CFP.
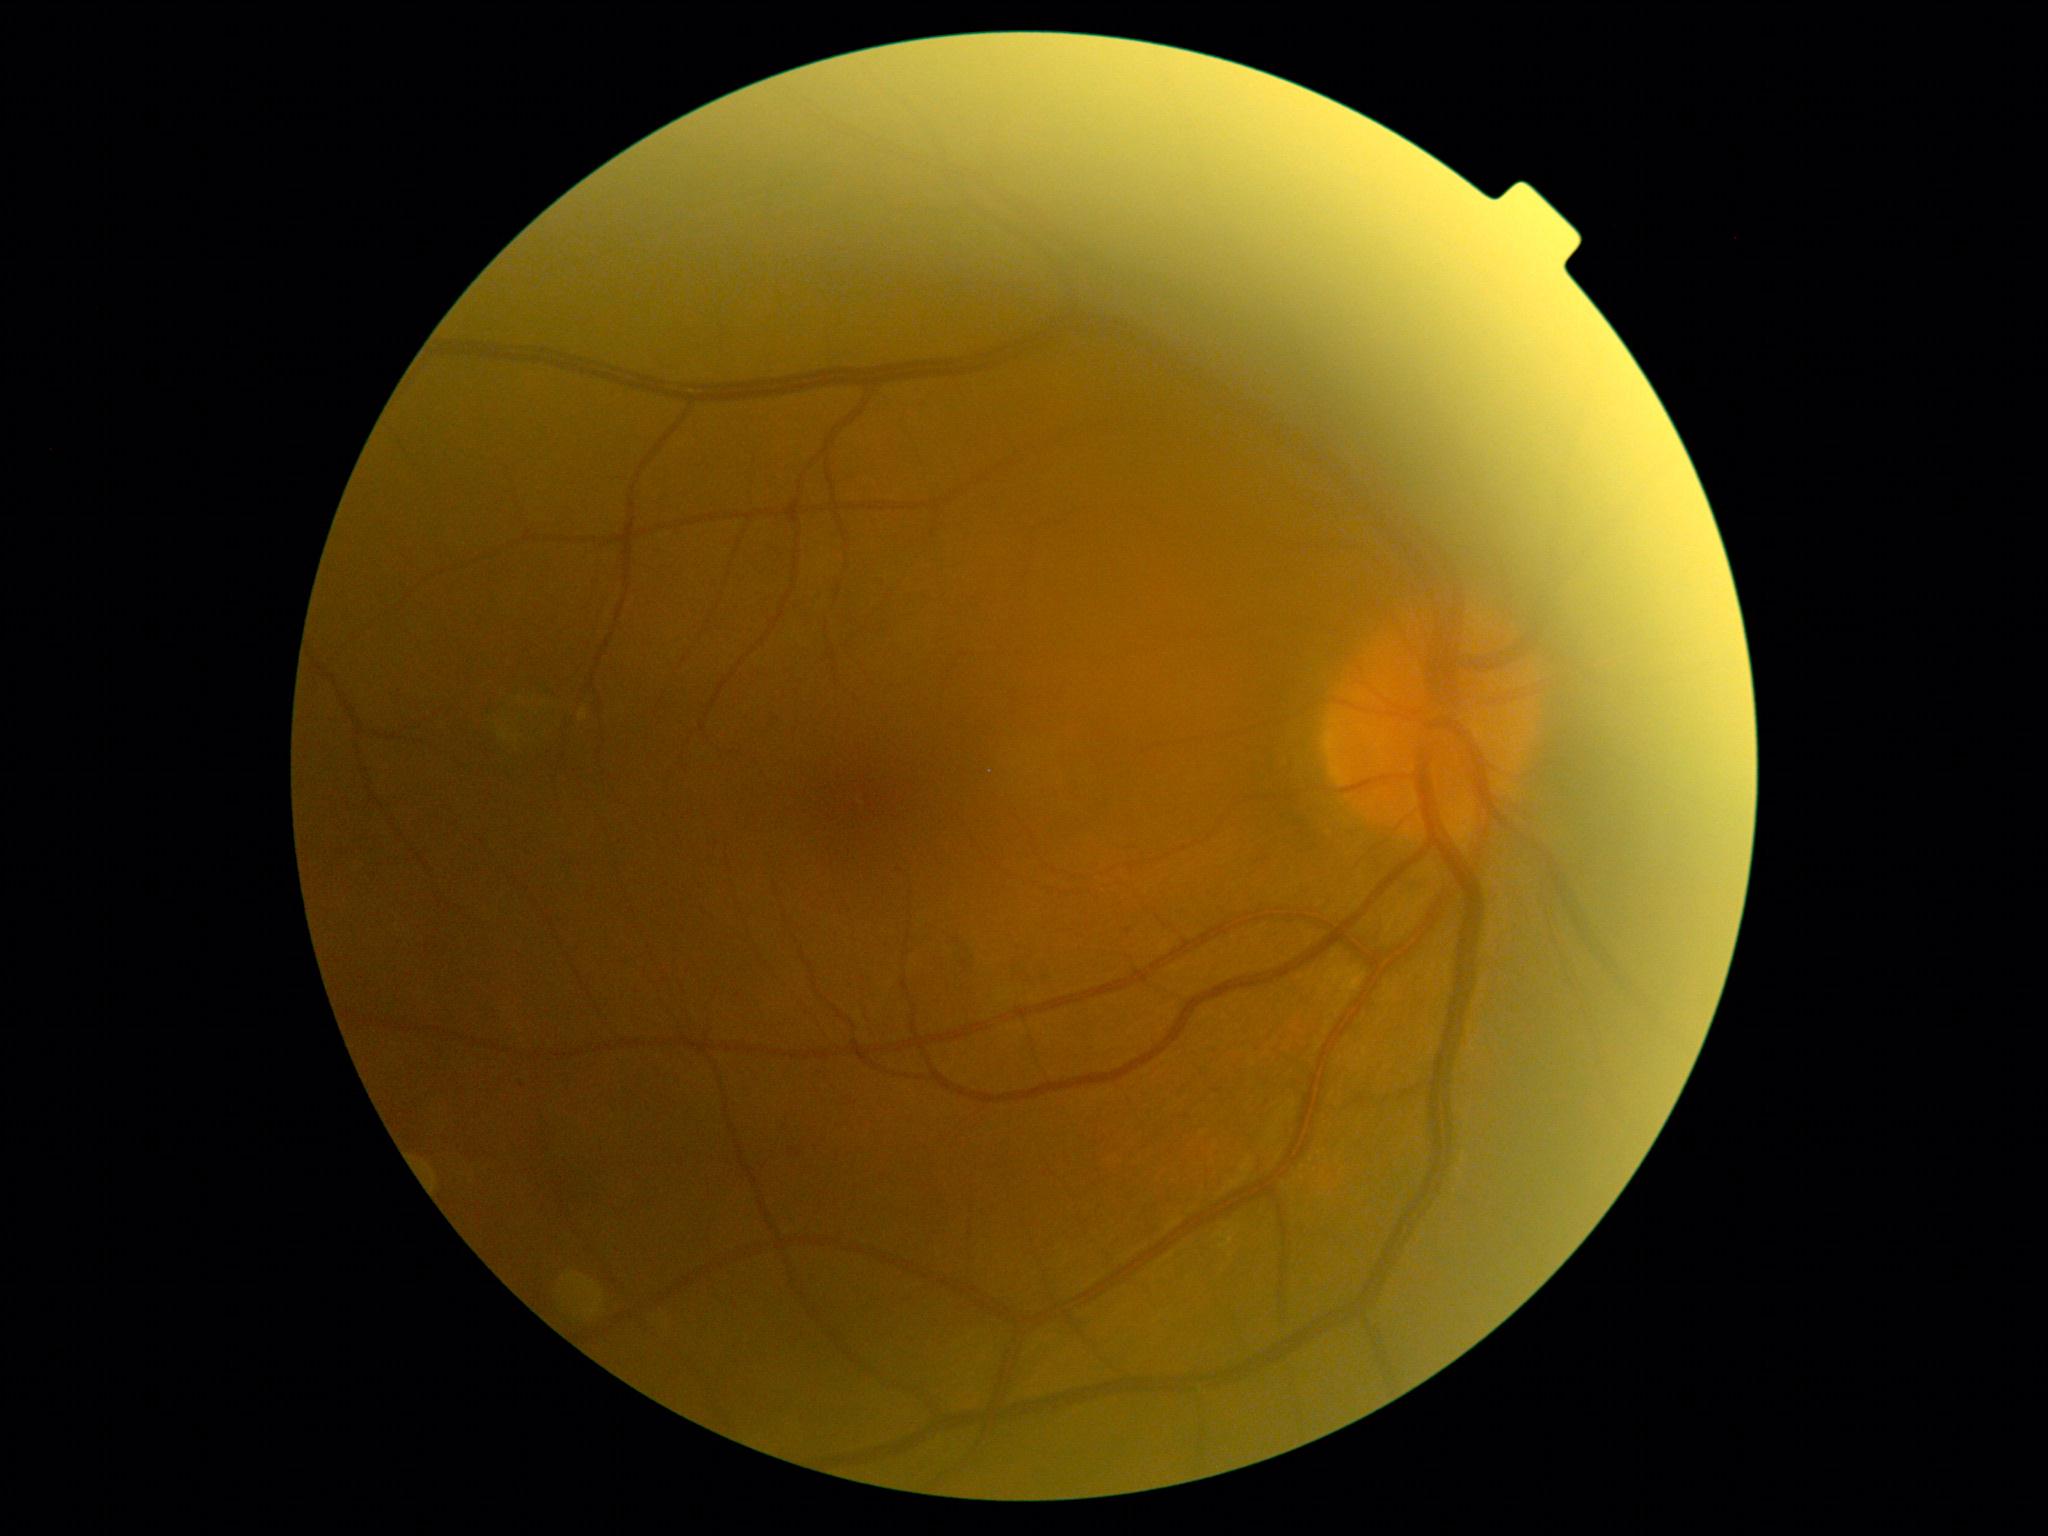 Diabetic retinopathy (DR) is grade 1 (mild NPDR).